Without pupil dilation. Acquired with a NIDEK AFC-230. 848x848px. 45 degree fundus photograph — 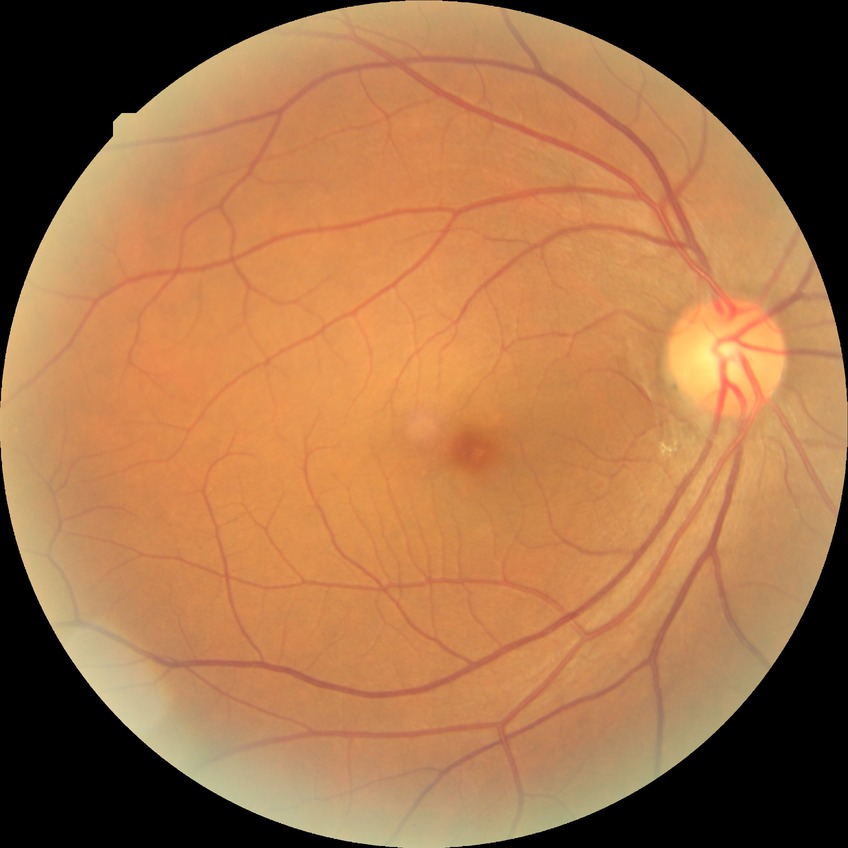
diabetic retinopathy (DR) = NDR (no diabetic retinopathy).